CFP. FOV: 45 degrees. 2184x1690:
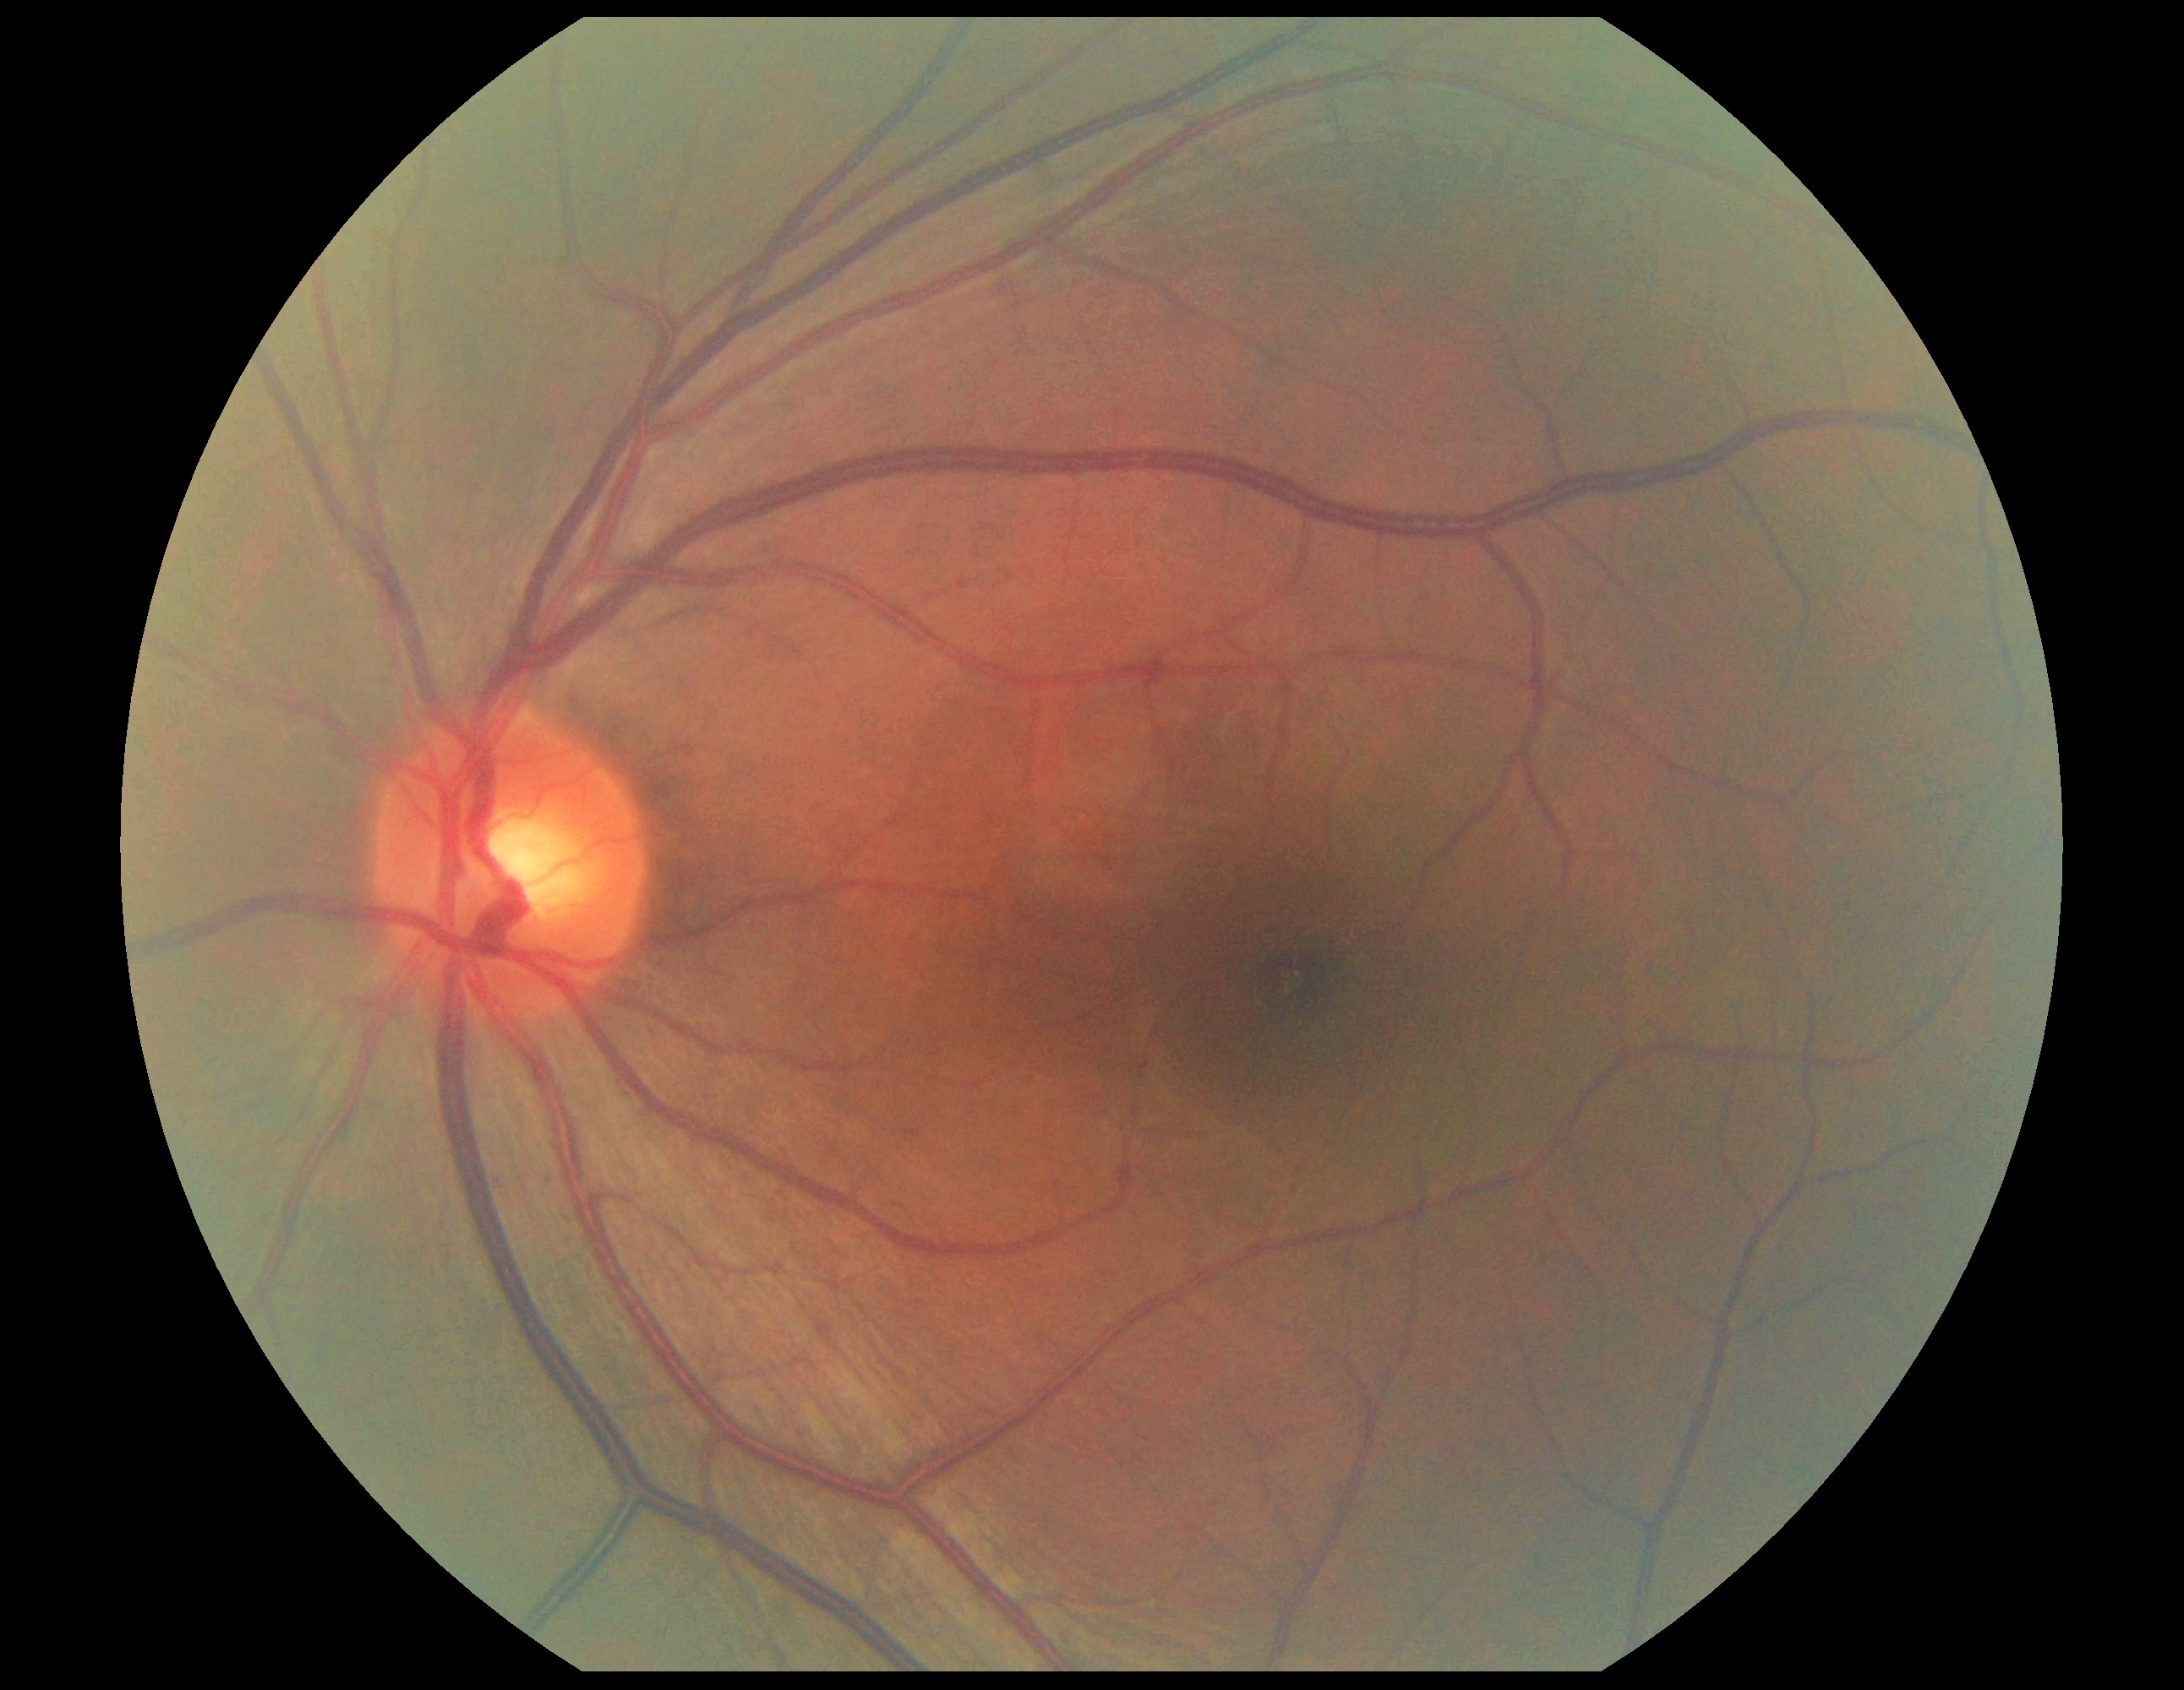
diabetic retinopathy (DR)@grade 0 (no apparent retinopathy).